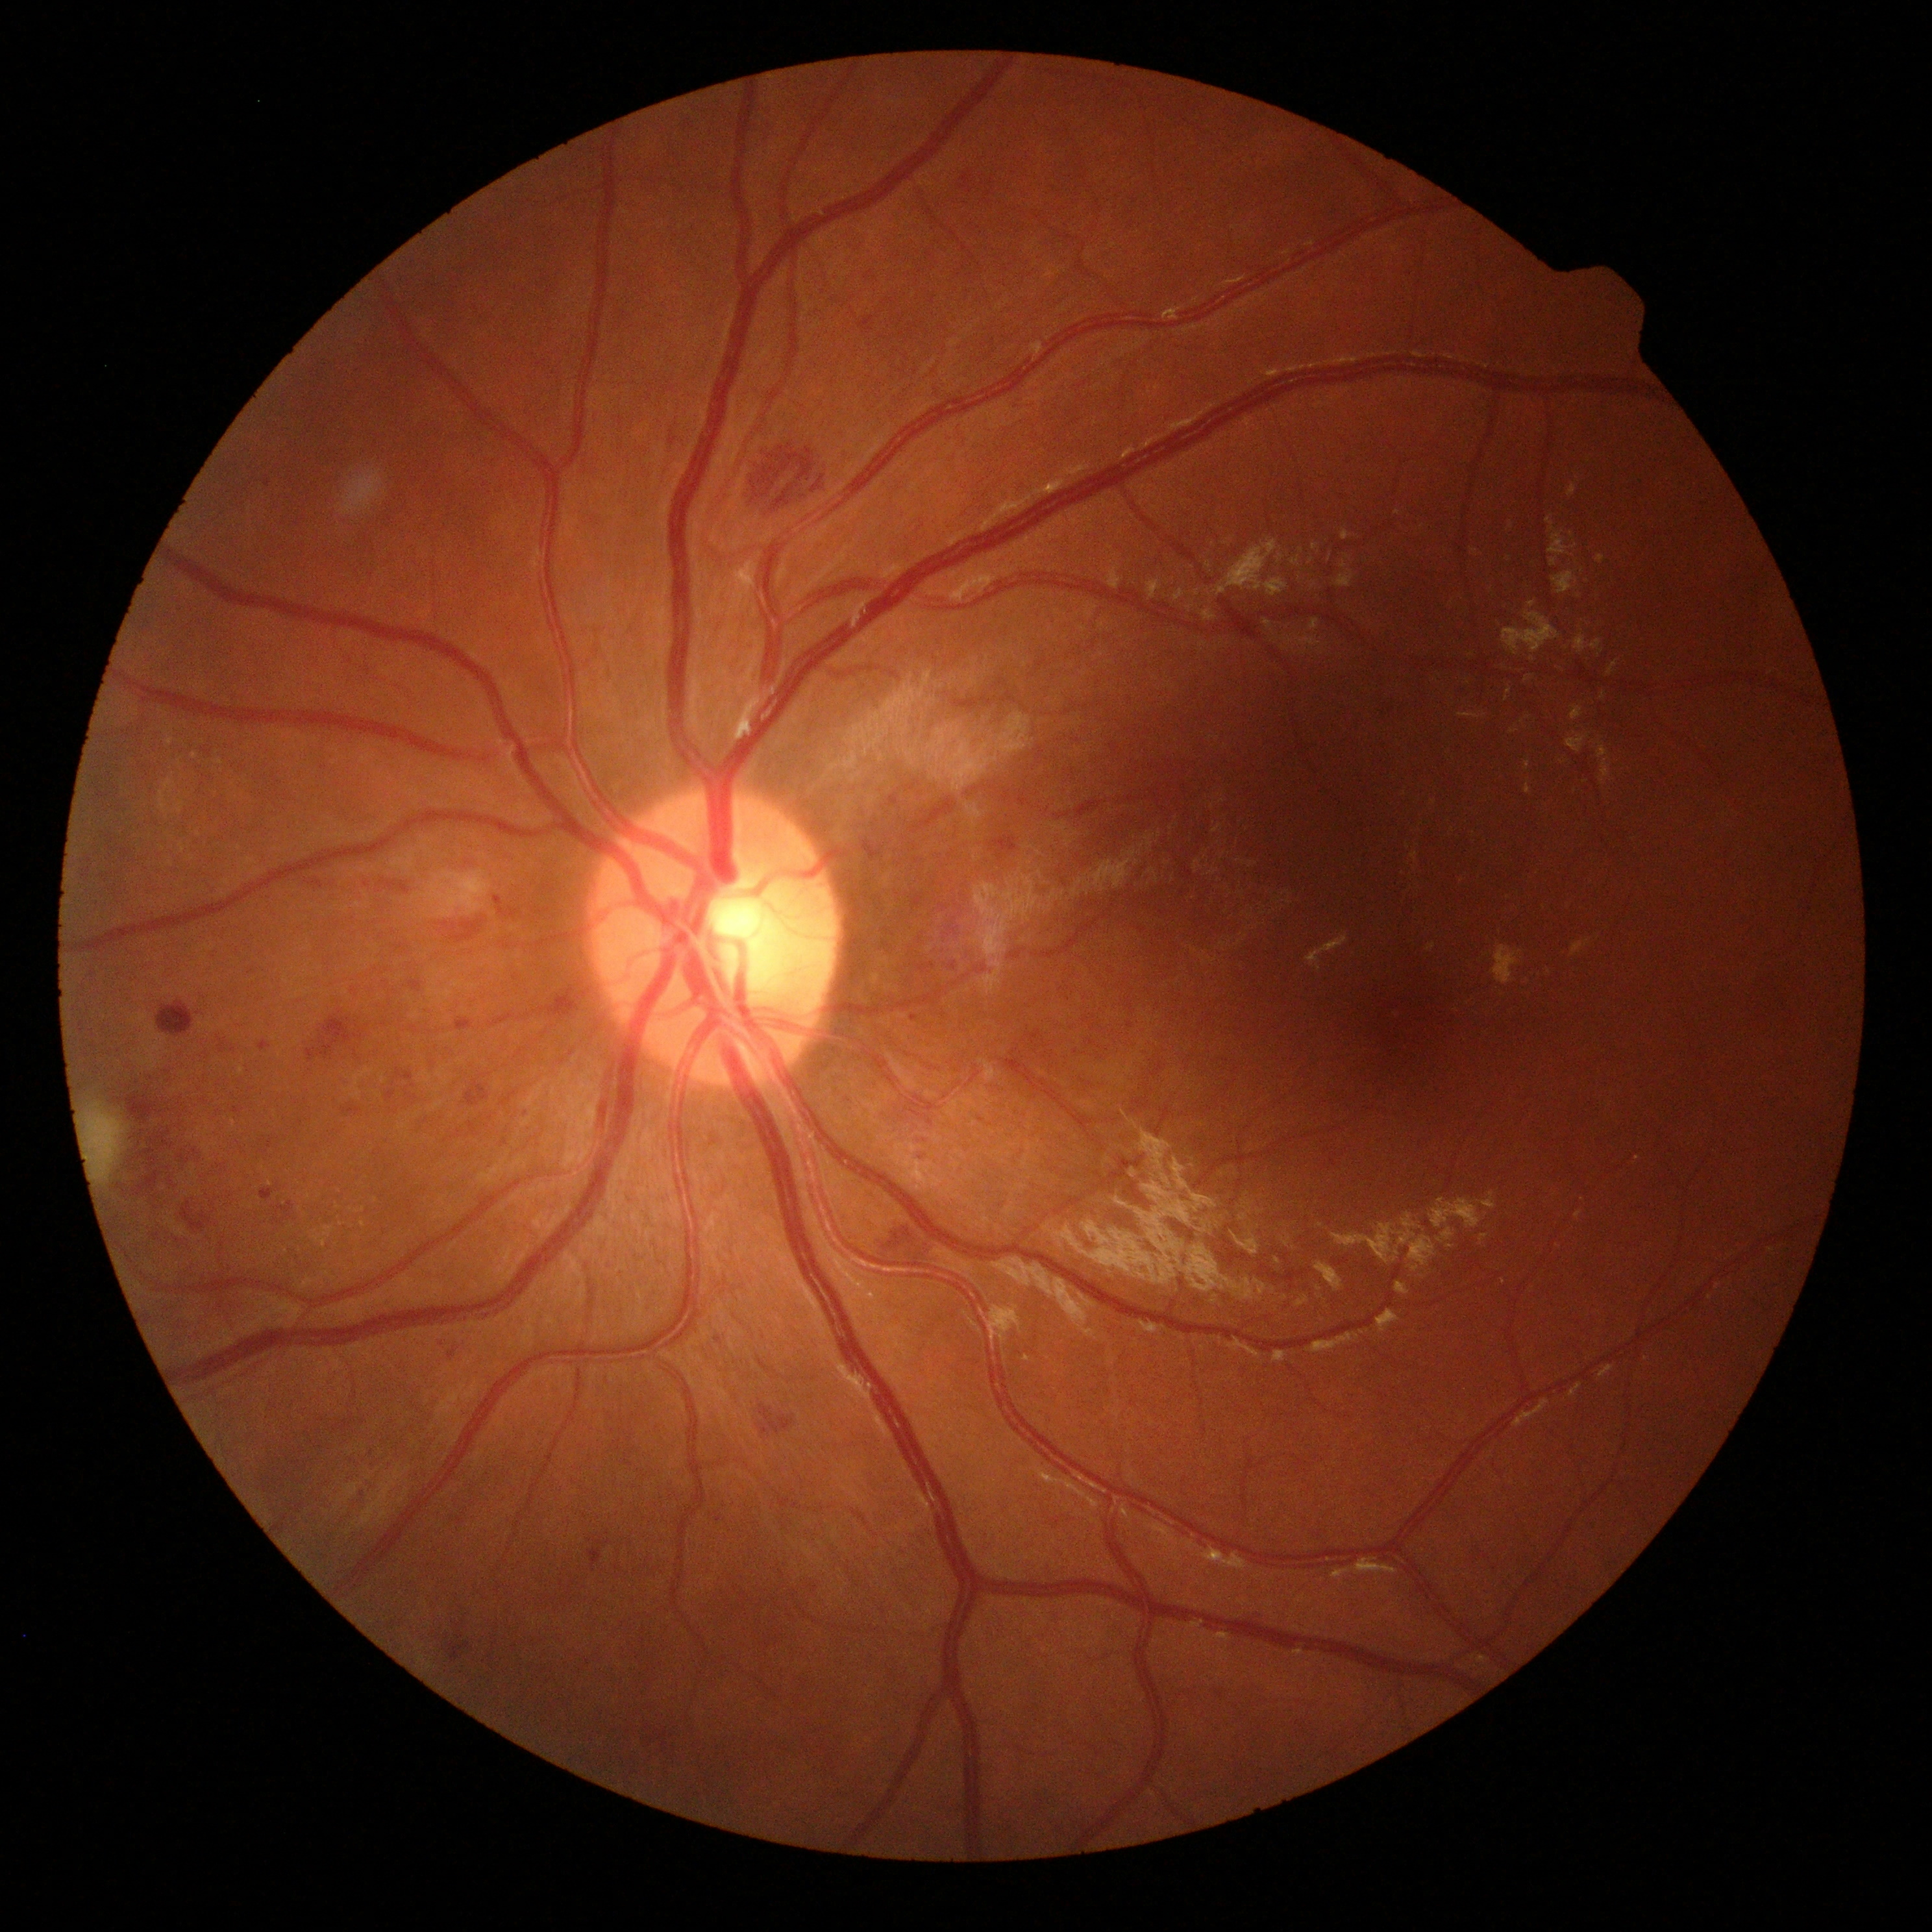
retinopathy grade: 2 — more than just microaneurysms but less than severe NPDR.